Color fundus image, 1659 by 2212 pixels:
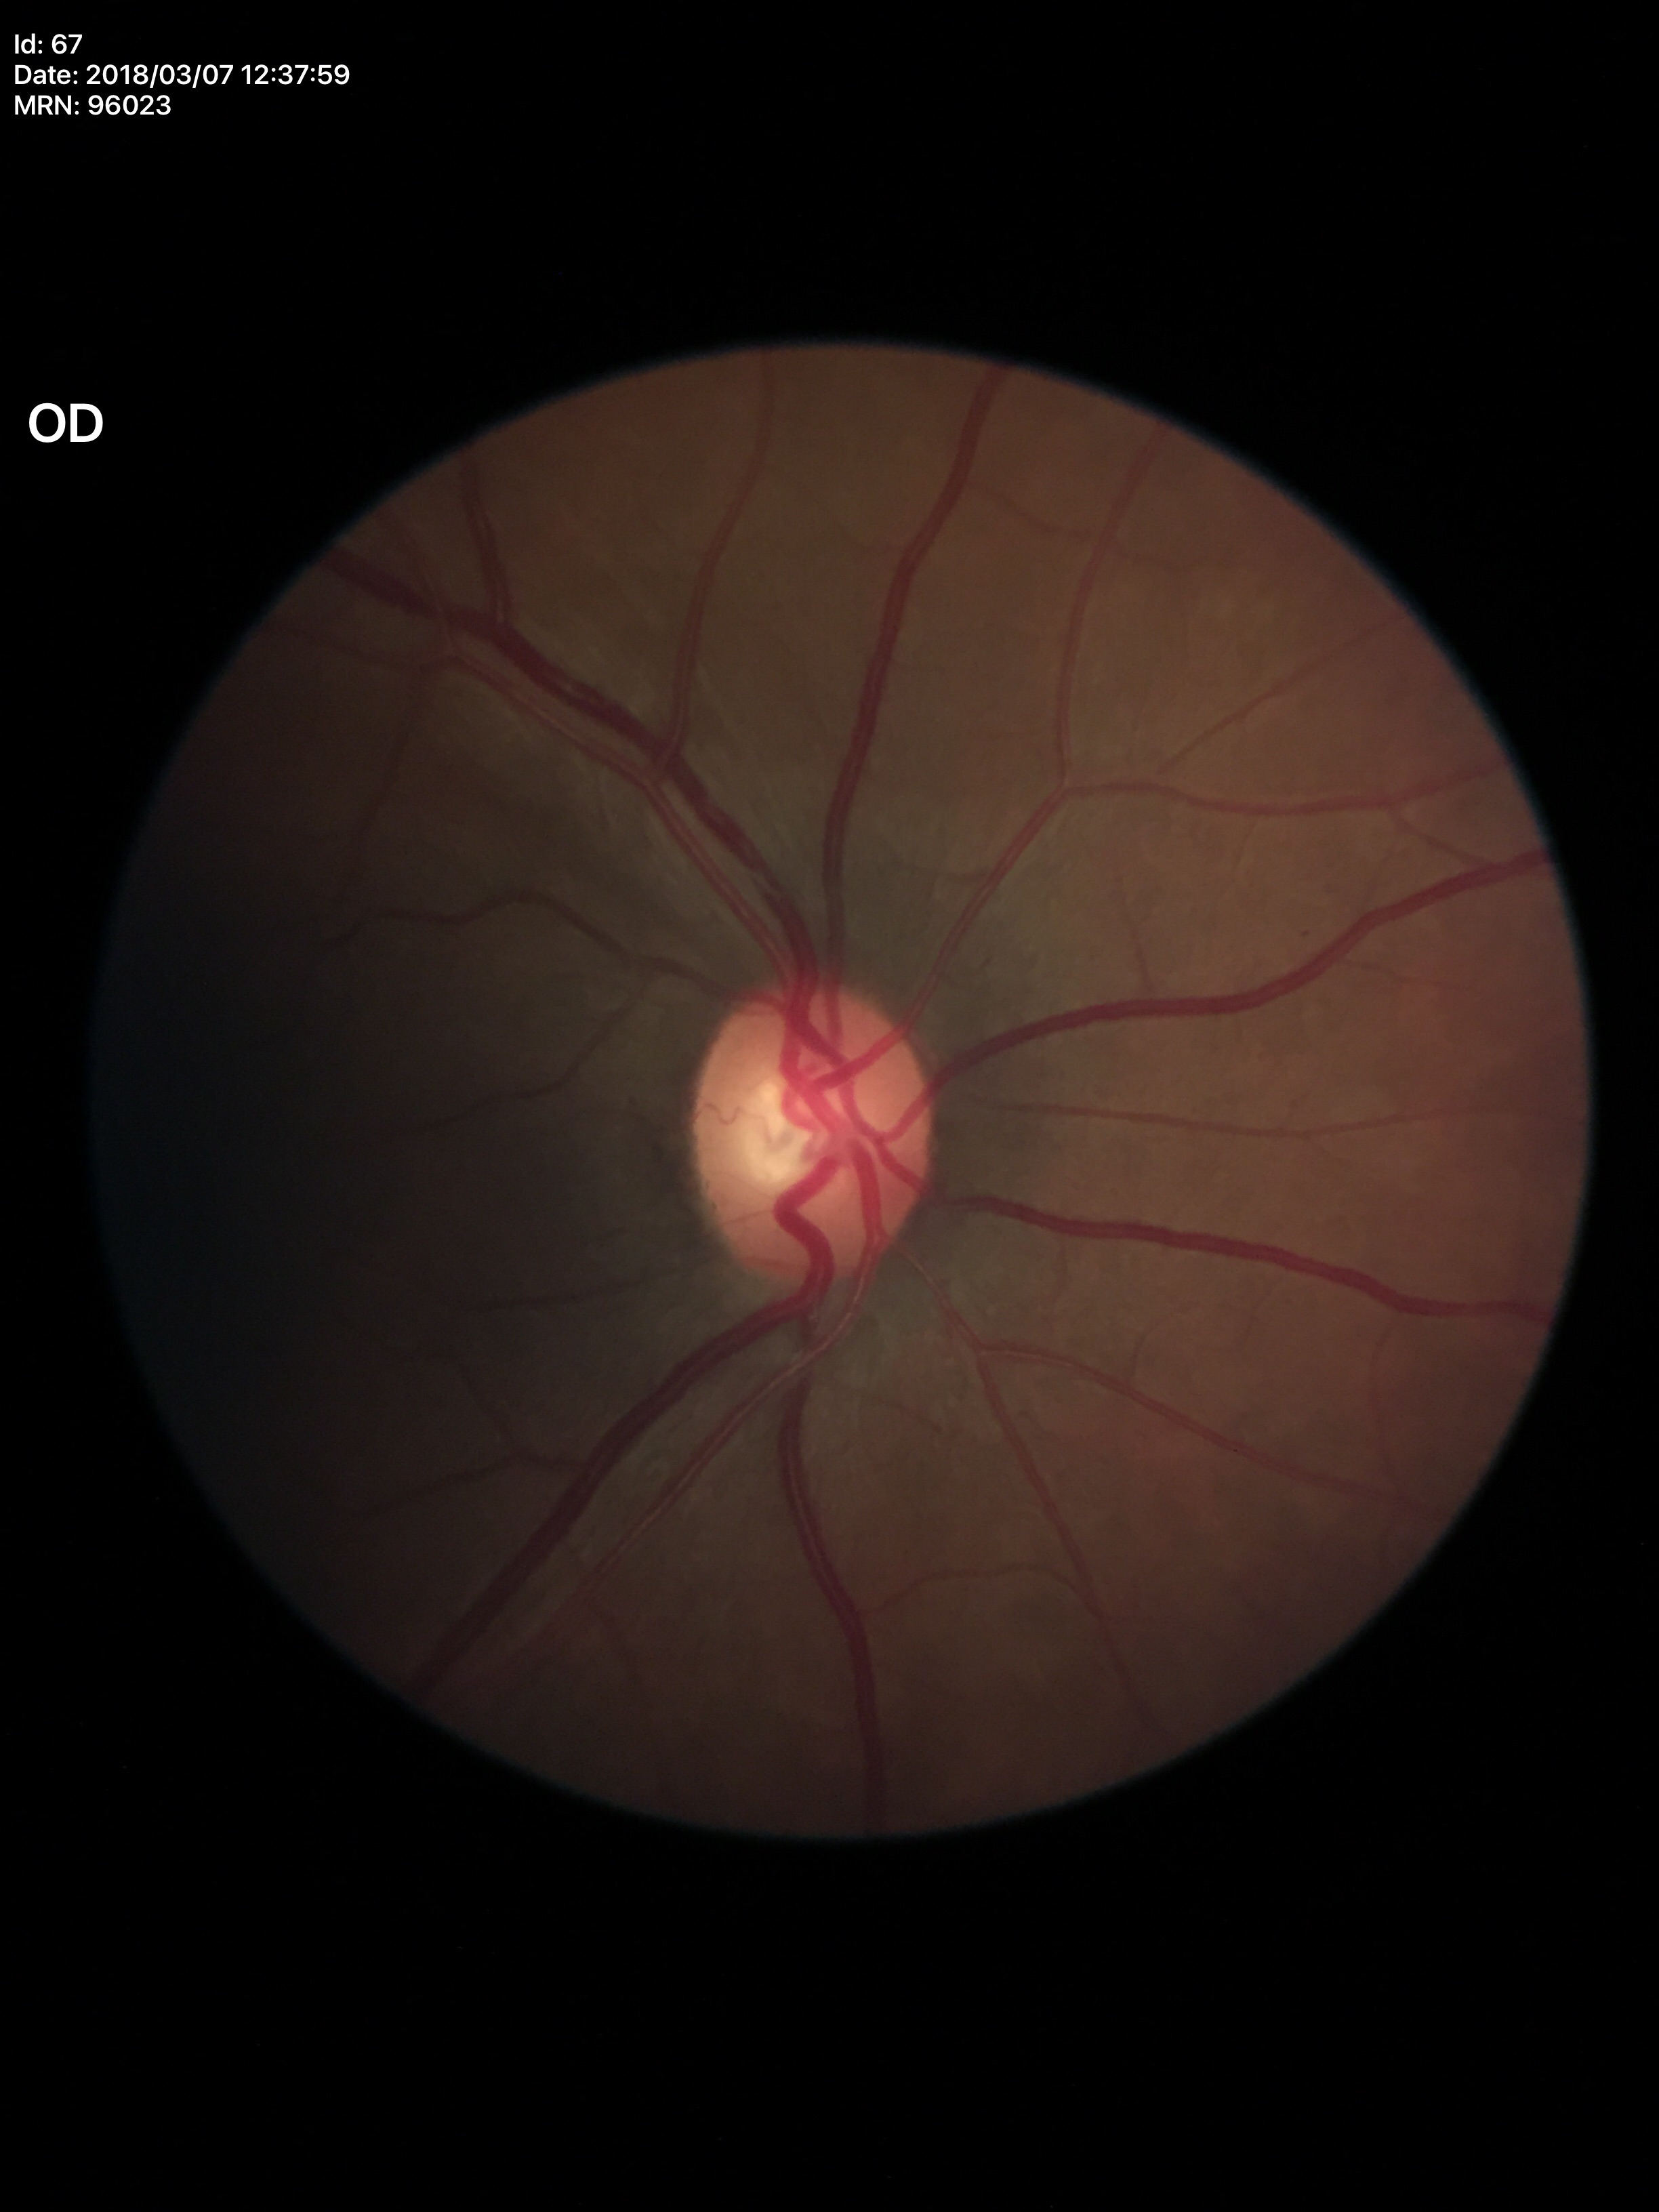
Findings:
* Glaucoma impression: no suspicious findings
* VCDR: 0.49
* HCDR: 0.56